Pediatric retinal photograph (wide-field). Camera: Clarity RetCam 3 (130° FOV):
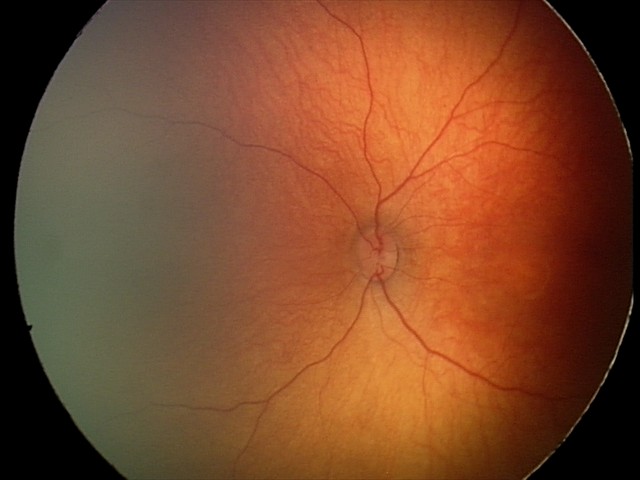

Q: What is the diagnosis from this examination?
A: no abnormal retinal findings